Infant wide-field retinal image; Clarity RetCam 3, 130° FOV.
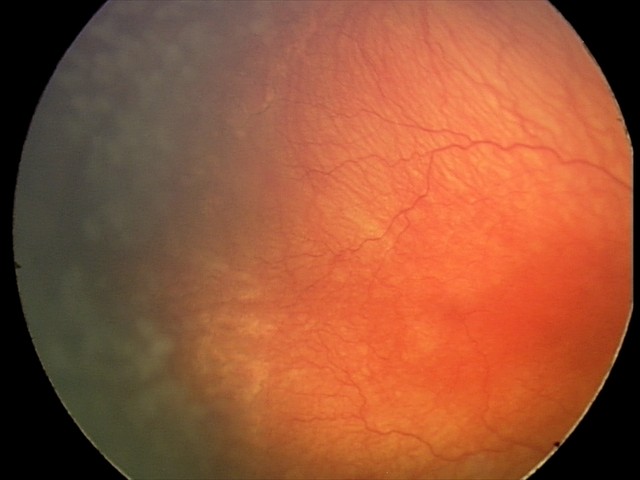

Examination diagnosed as aggressive retinopathy of prematurity.
Plus disease present.